1240x1240px. Wide-field fundus photograph from neonatal ROP screening — 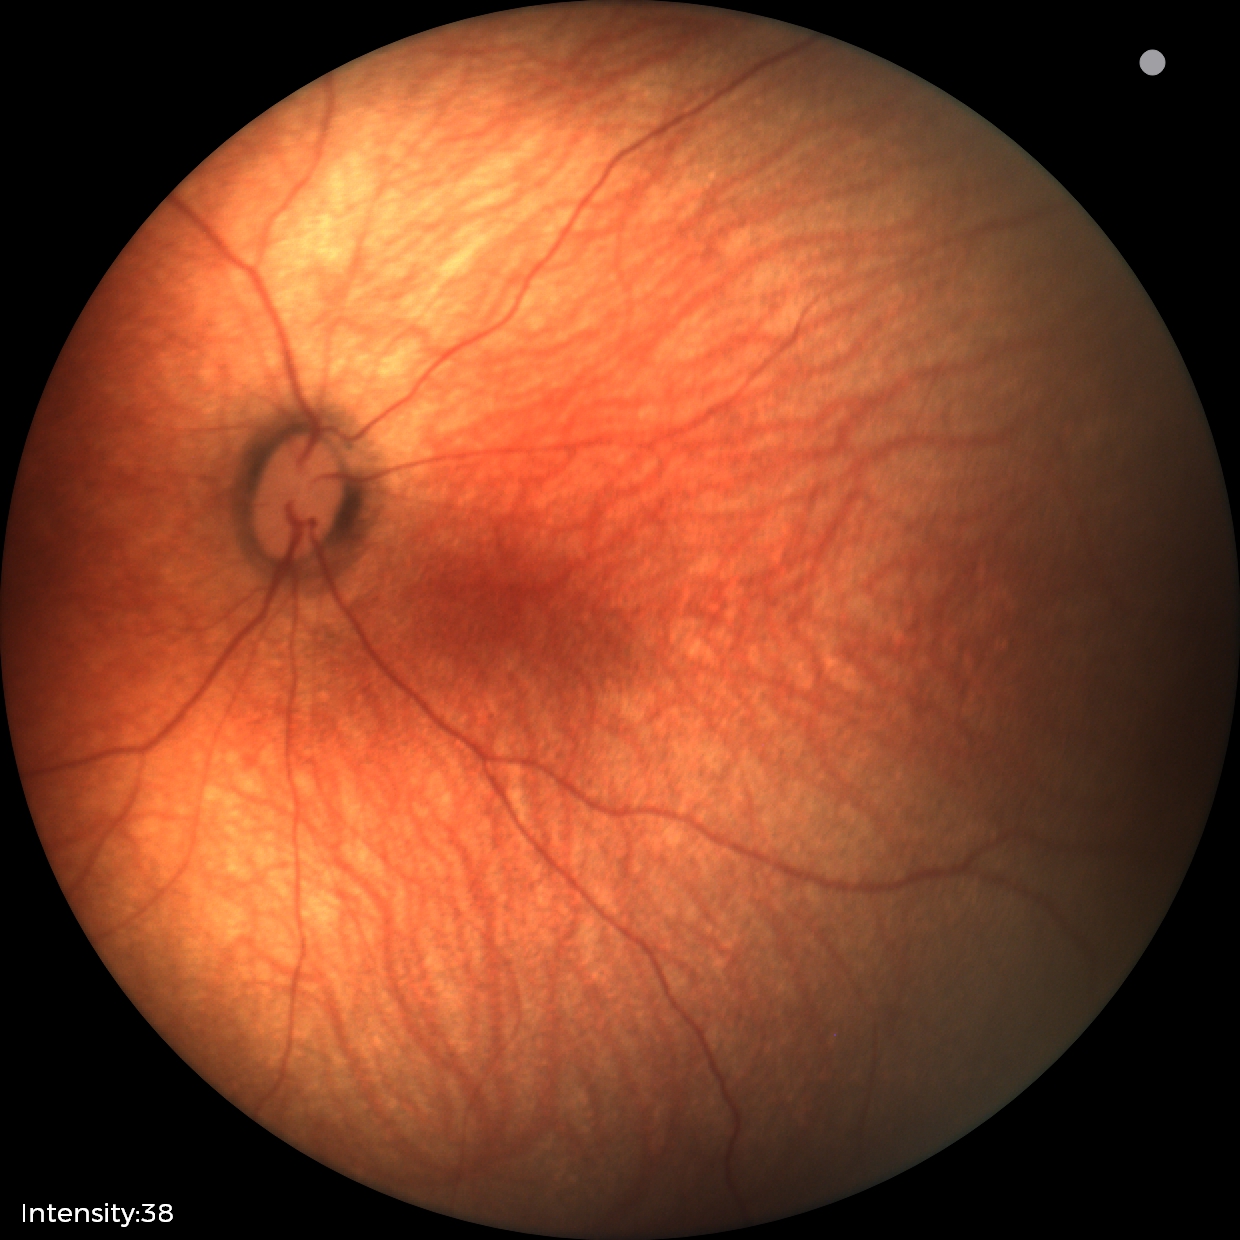

Screening examination diagnosed as physiological.